45-degree field of view · 1932x1932px:
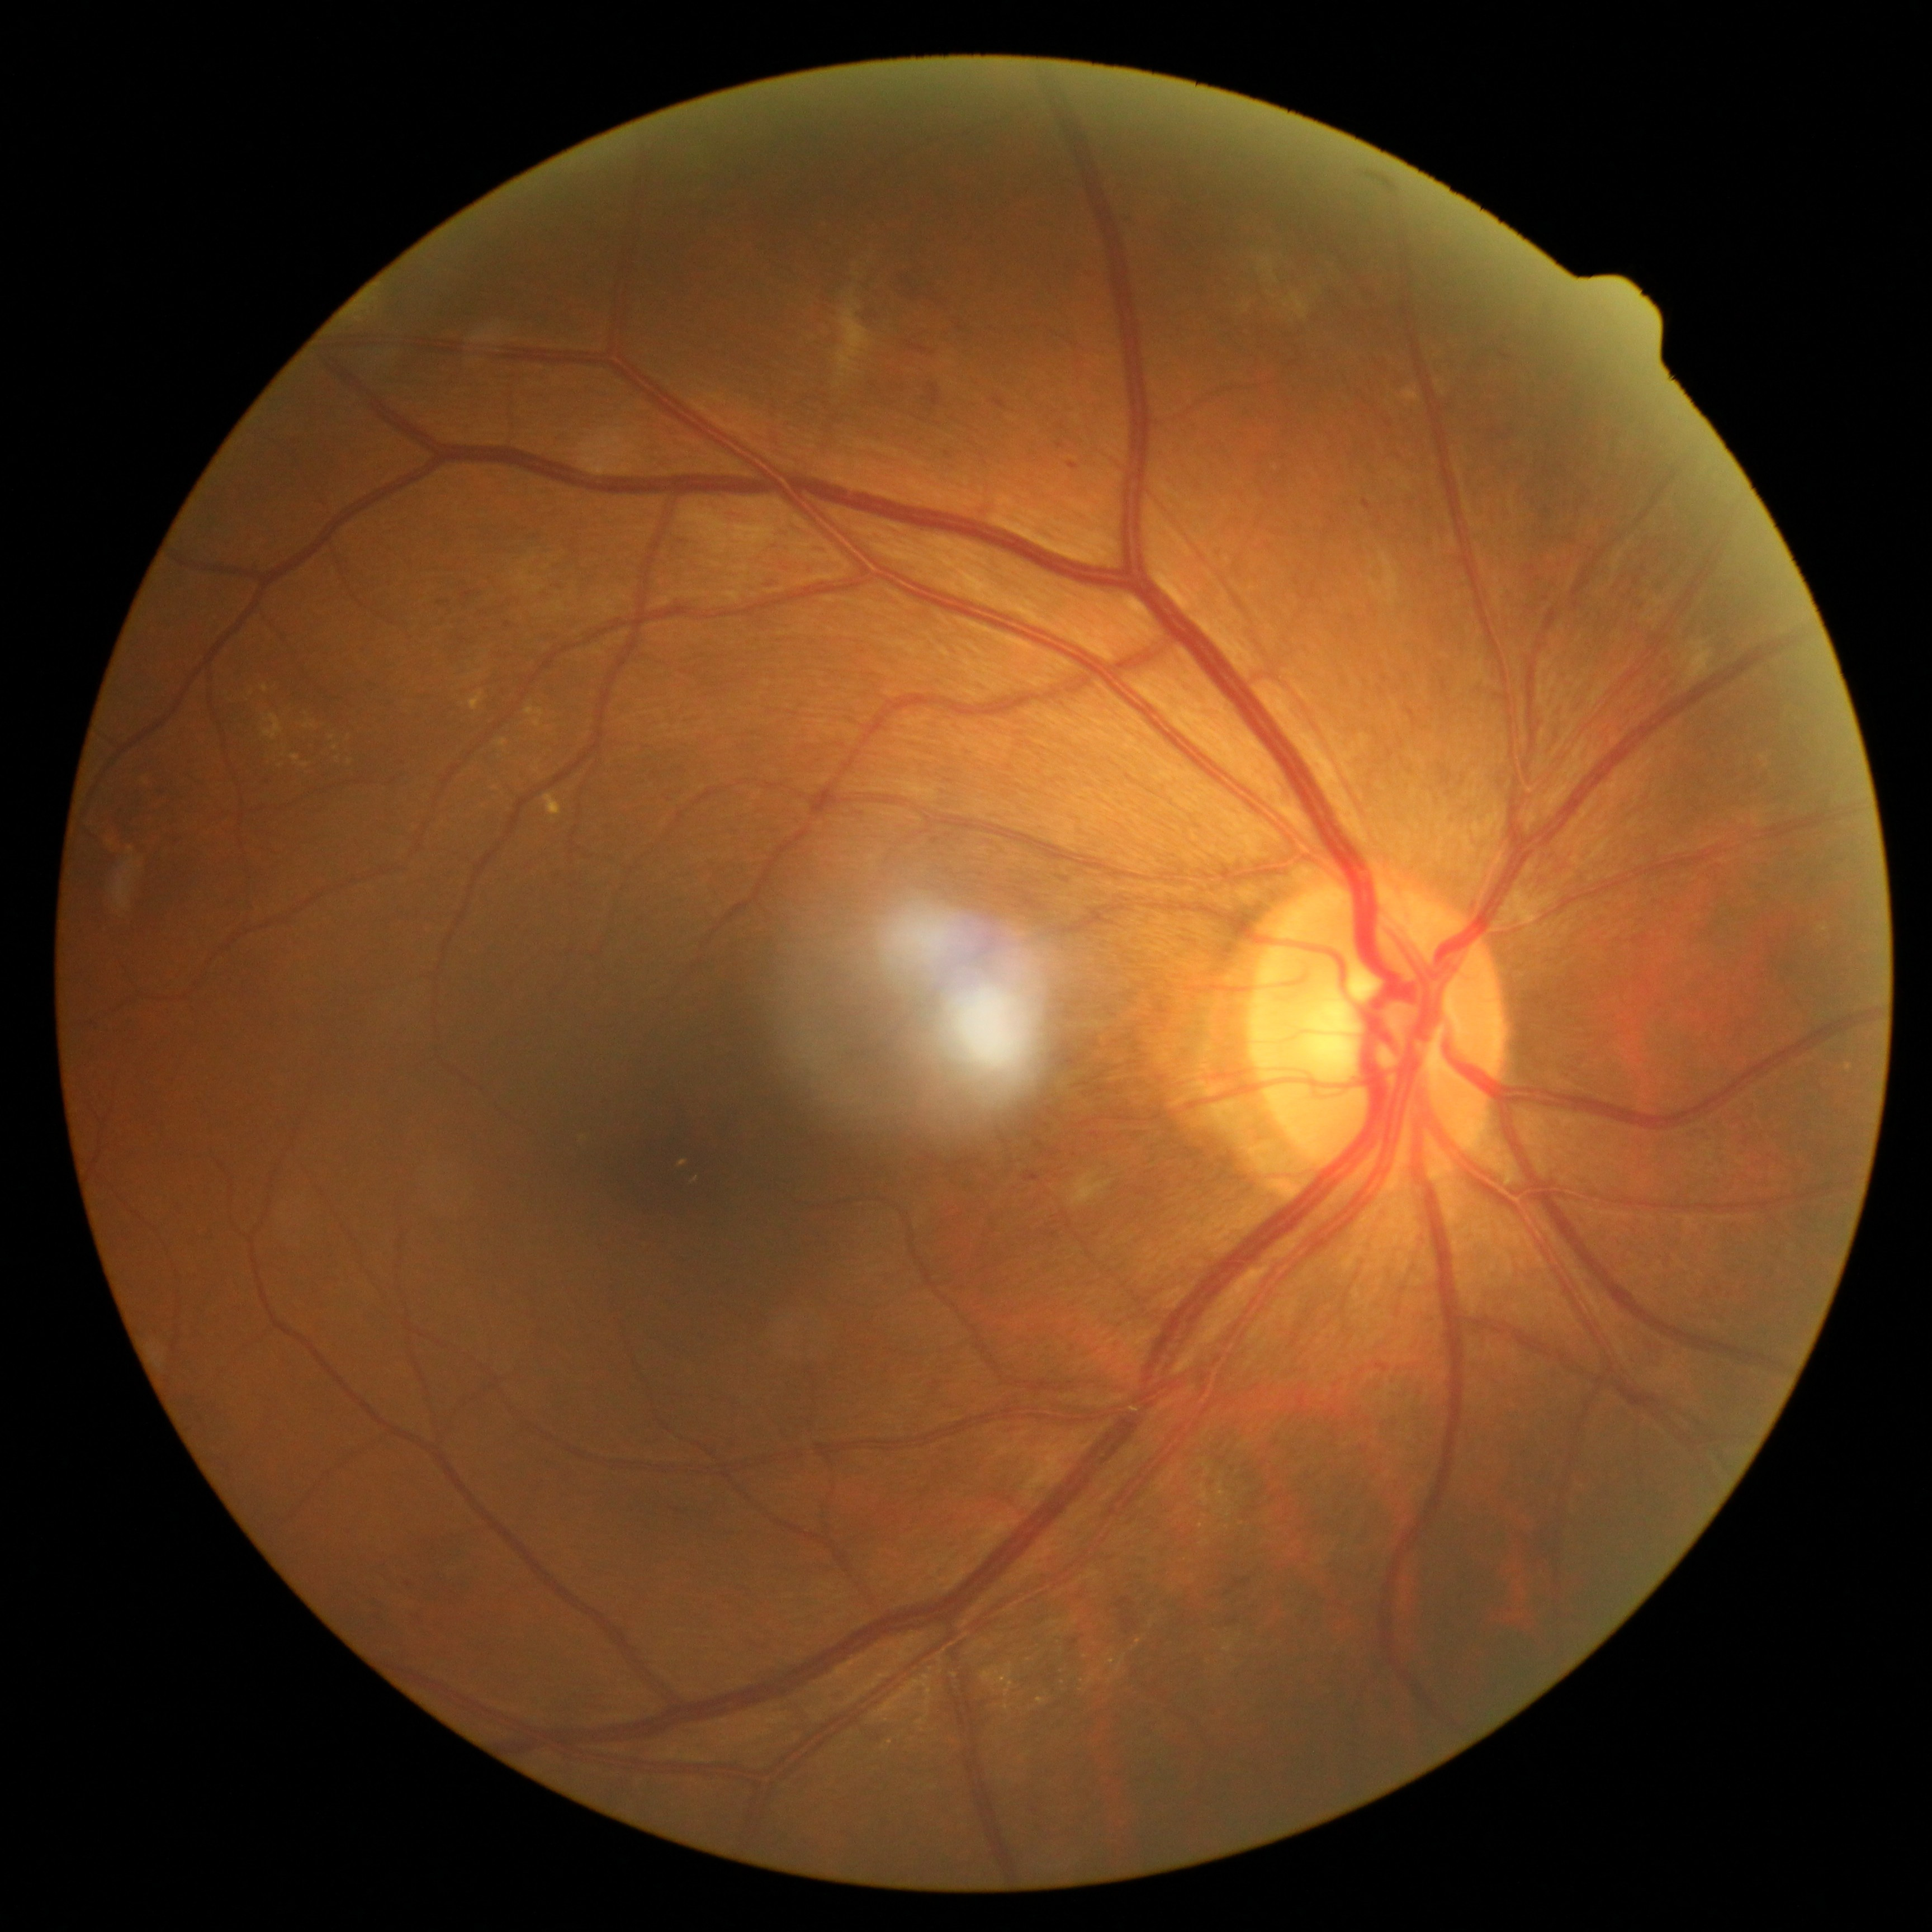 Diabetic retinopathy (DR): grade 2 (moderate NPDR).